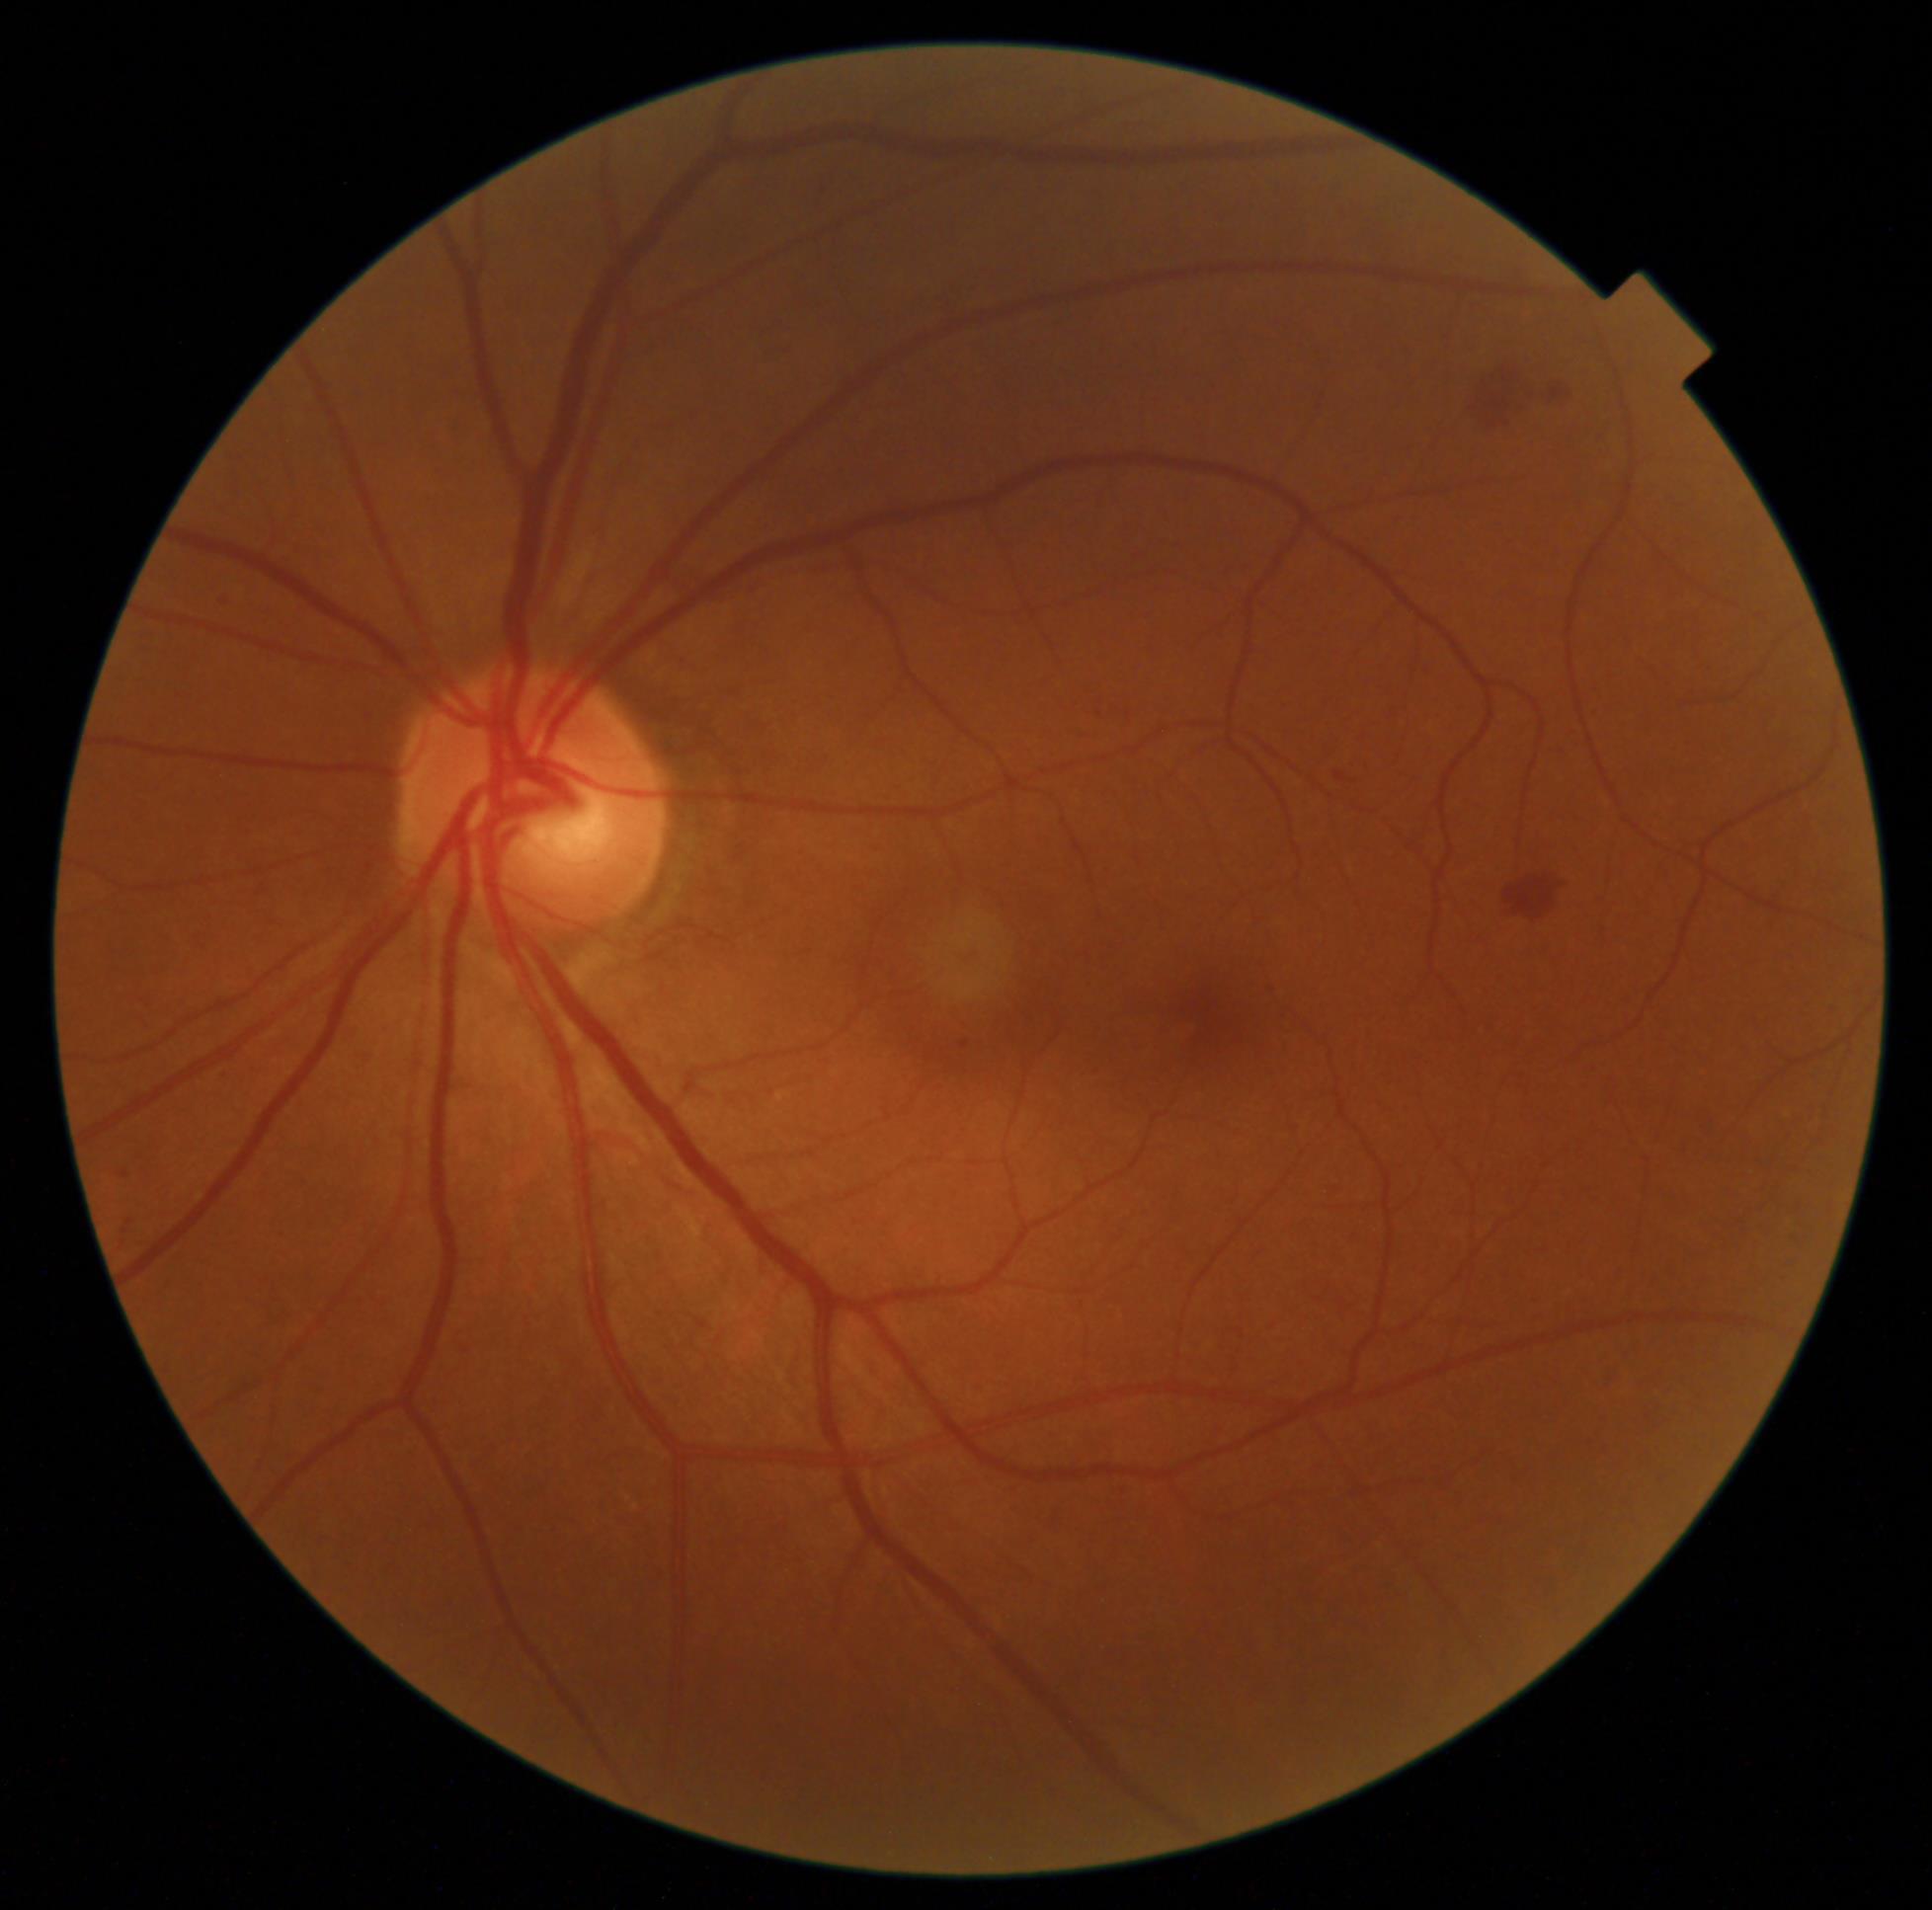

DR stage = 2/4 — more than just microaneurysms but less than severe NPDR.